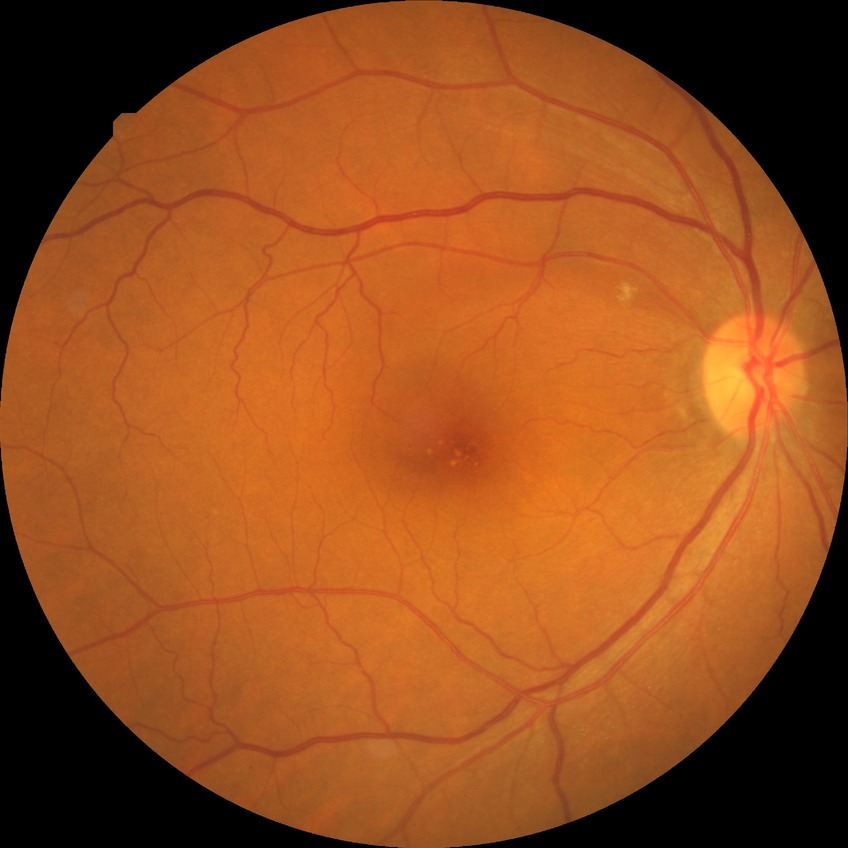 No DR findings. DR stage: NDR.